640 by 480 pixels; pediatric wide-field fundus photograph.
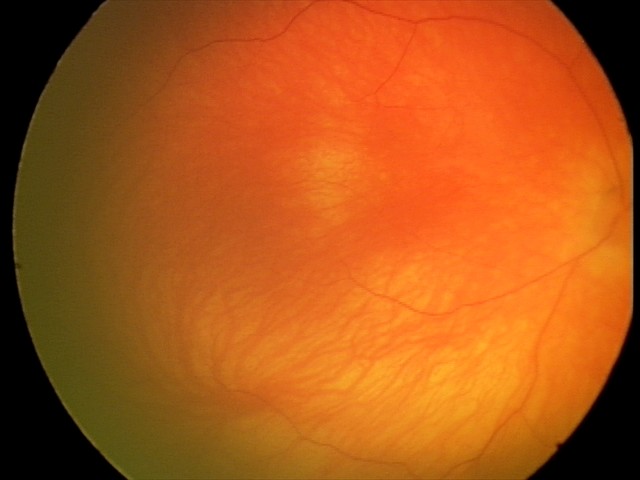

Screening diagnosis: no abnormal retinal findings.